Image size 2048x1536, fundus photo, 45-degree field of view — 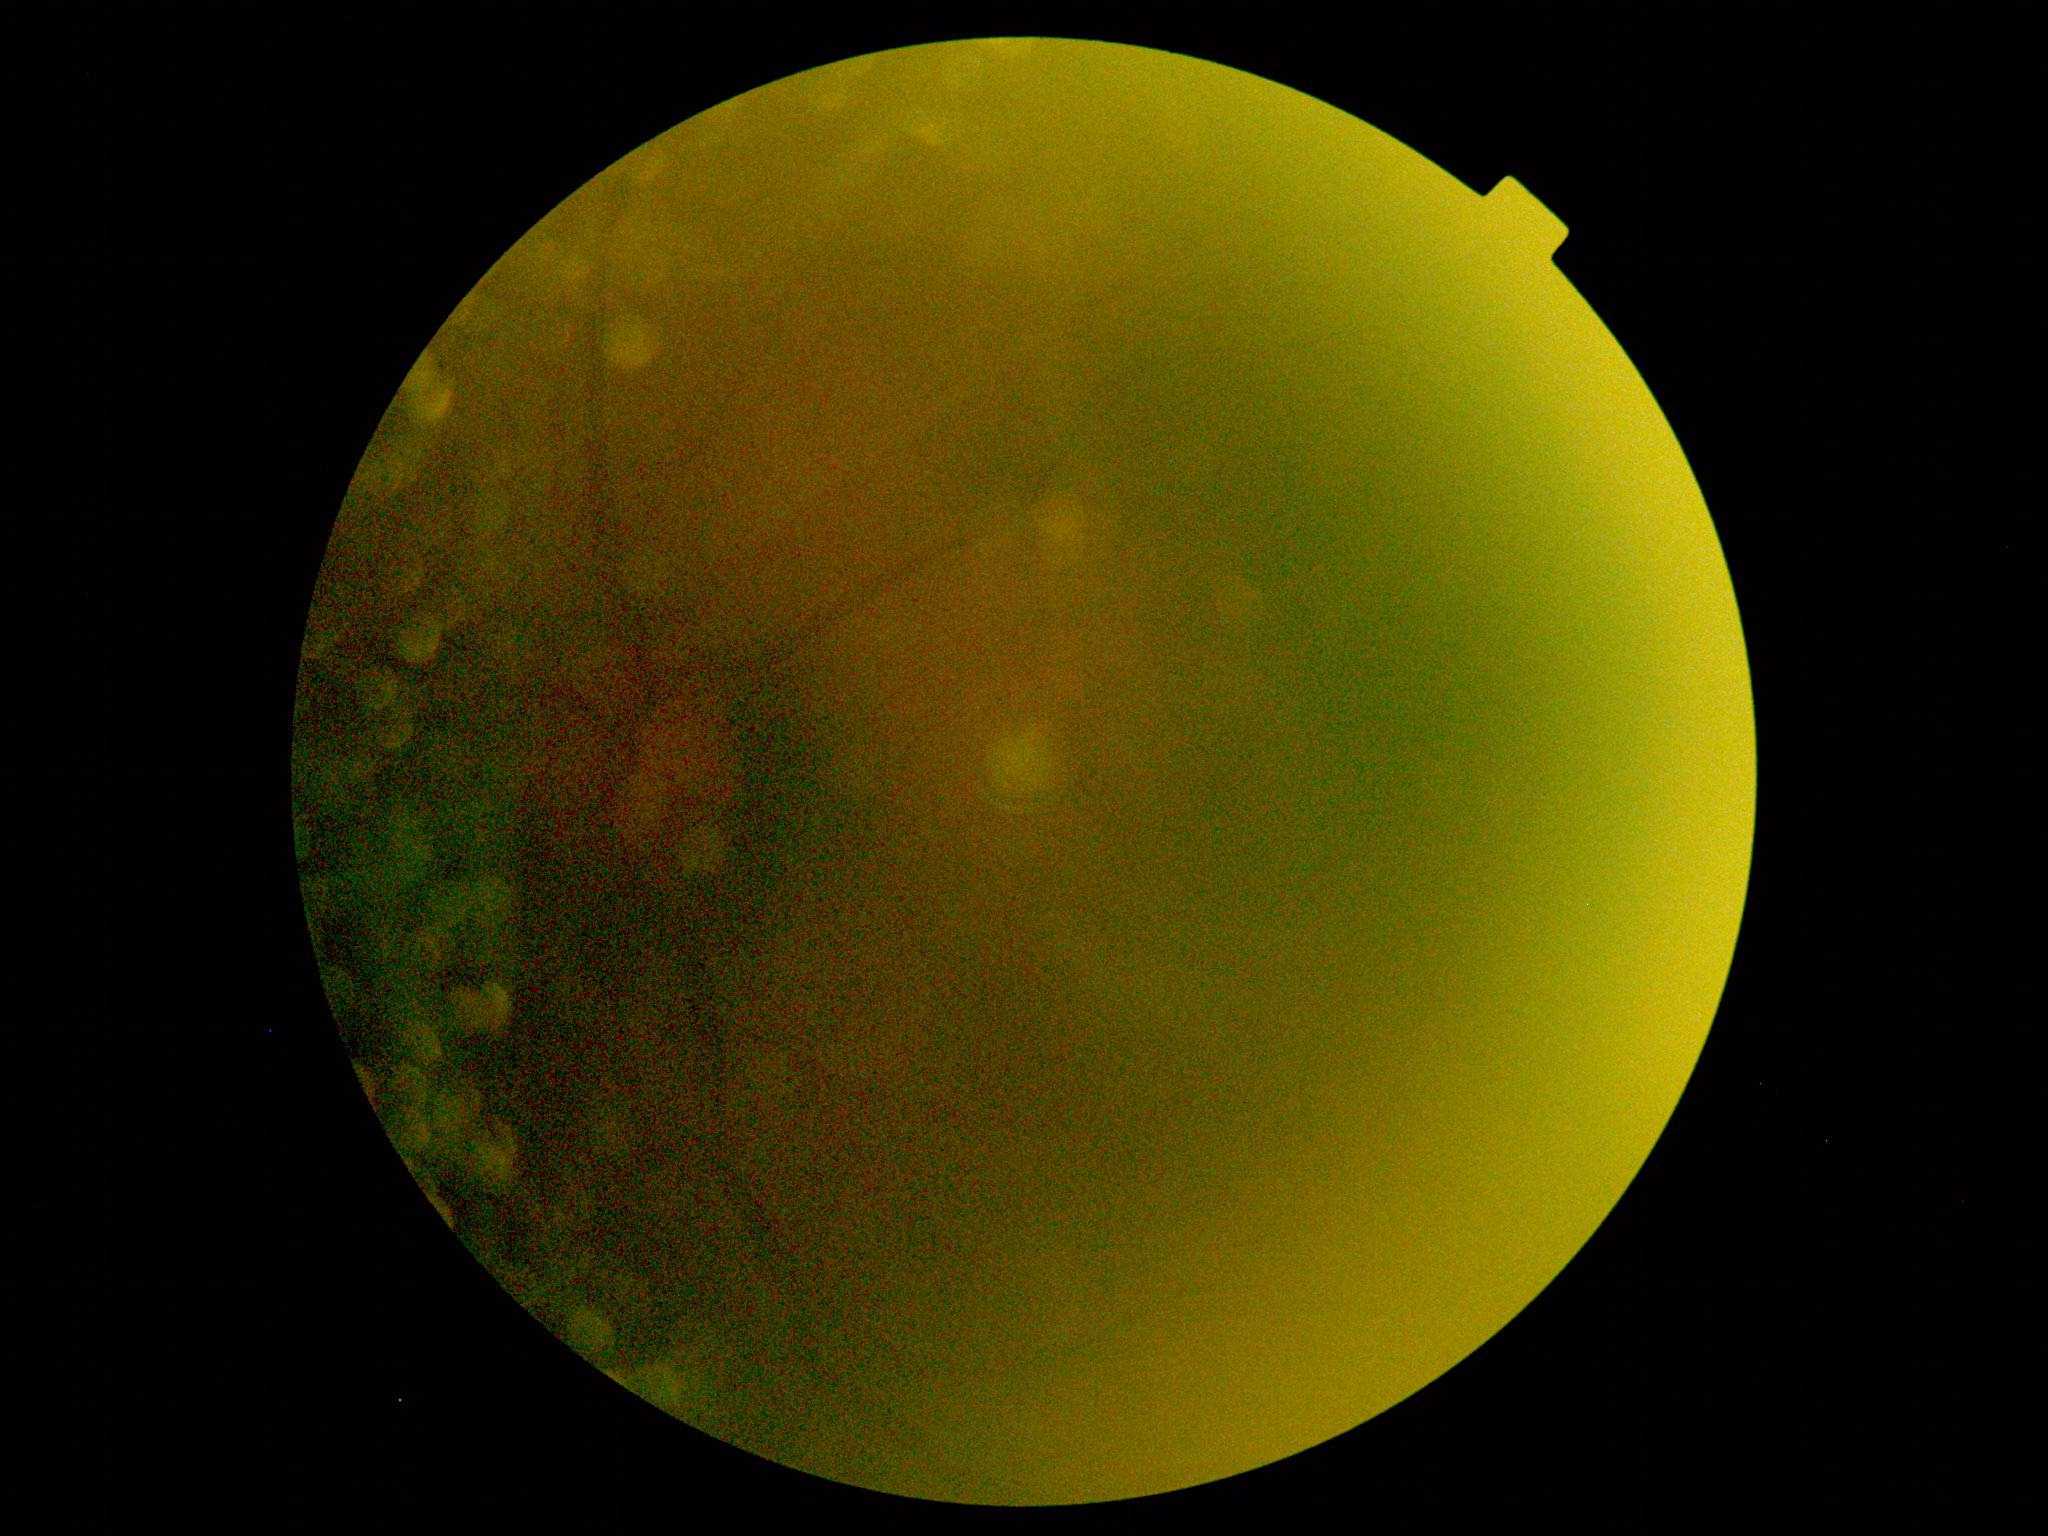
{"quality": "too poor for DR grading", "dr_grade": "ungradable"}